Pediatric wide-field fundus photograph · 1440 x 1080 pixels: 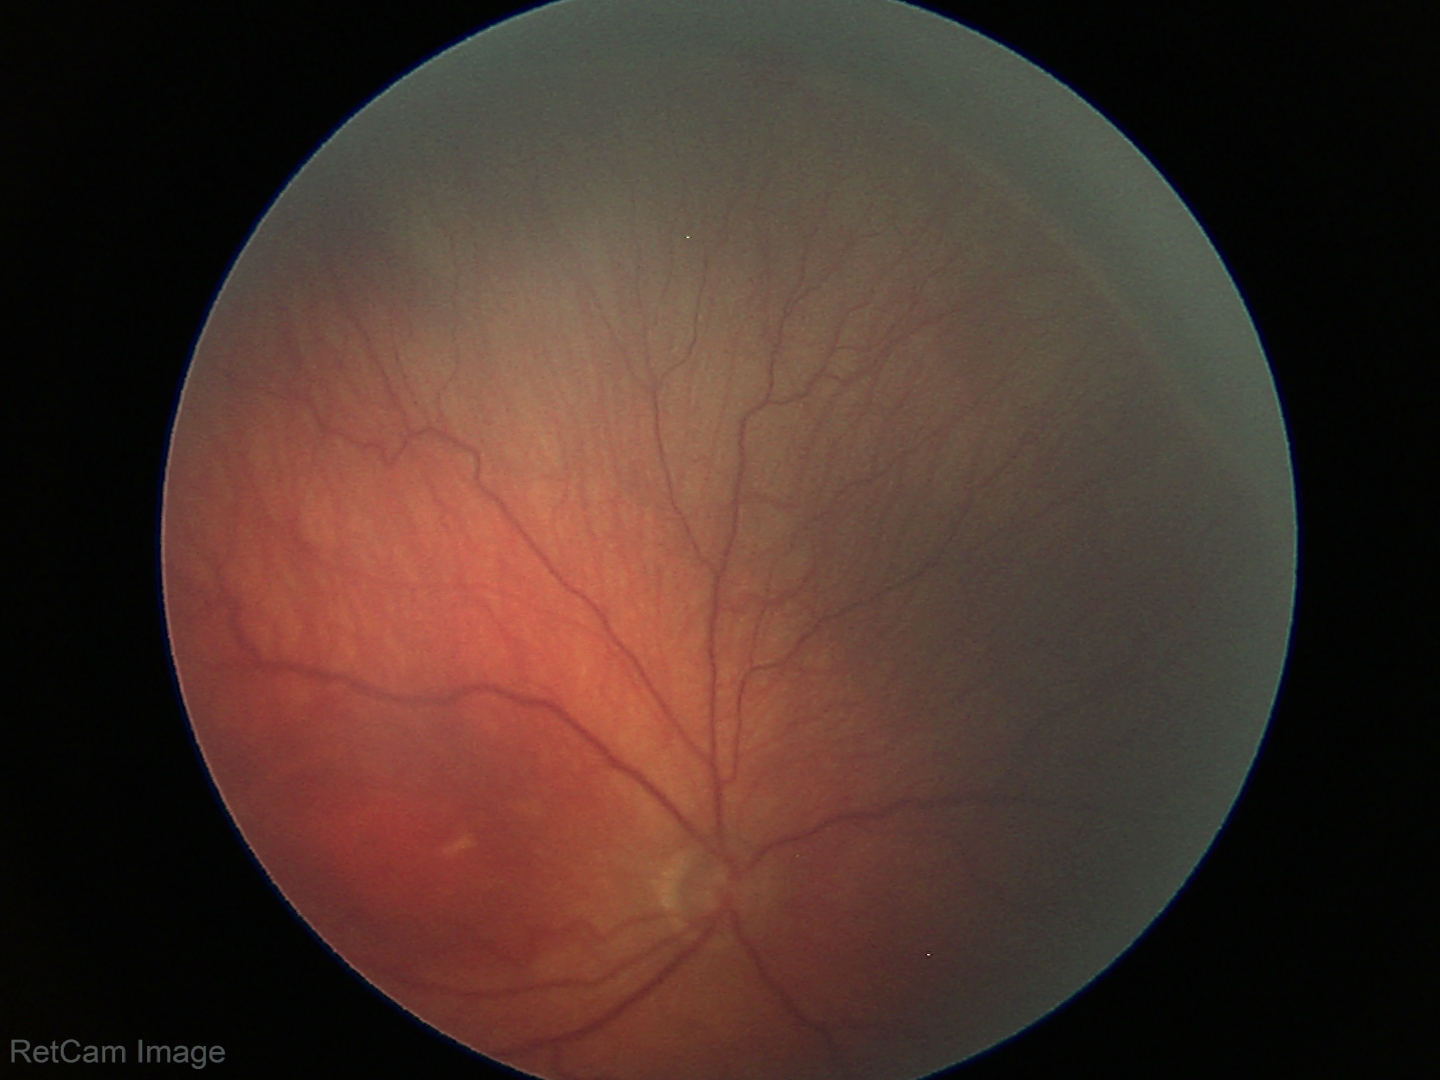

Diagnosis = retinopathy of prematurity stage 3.